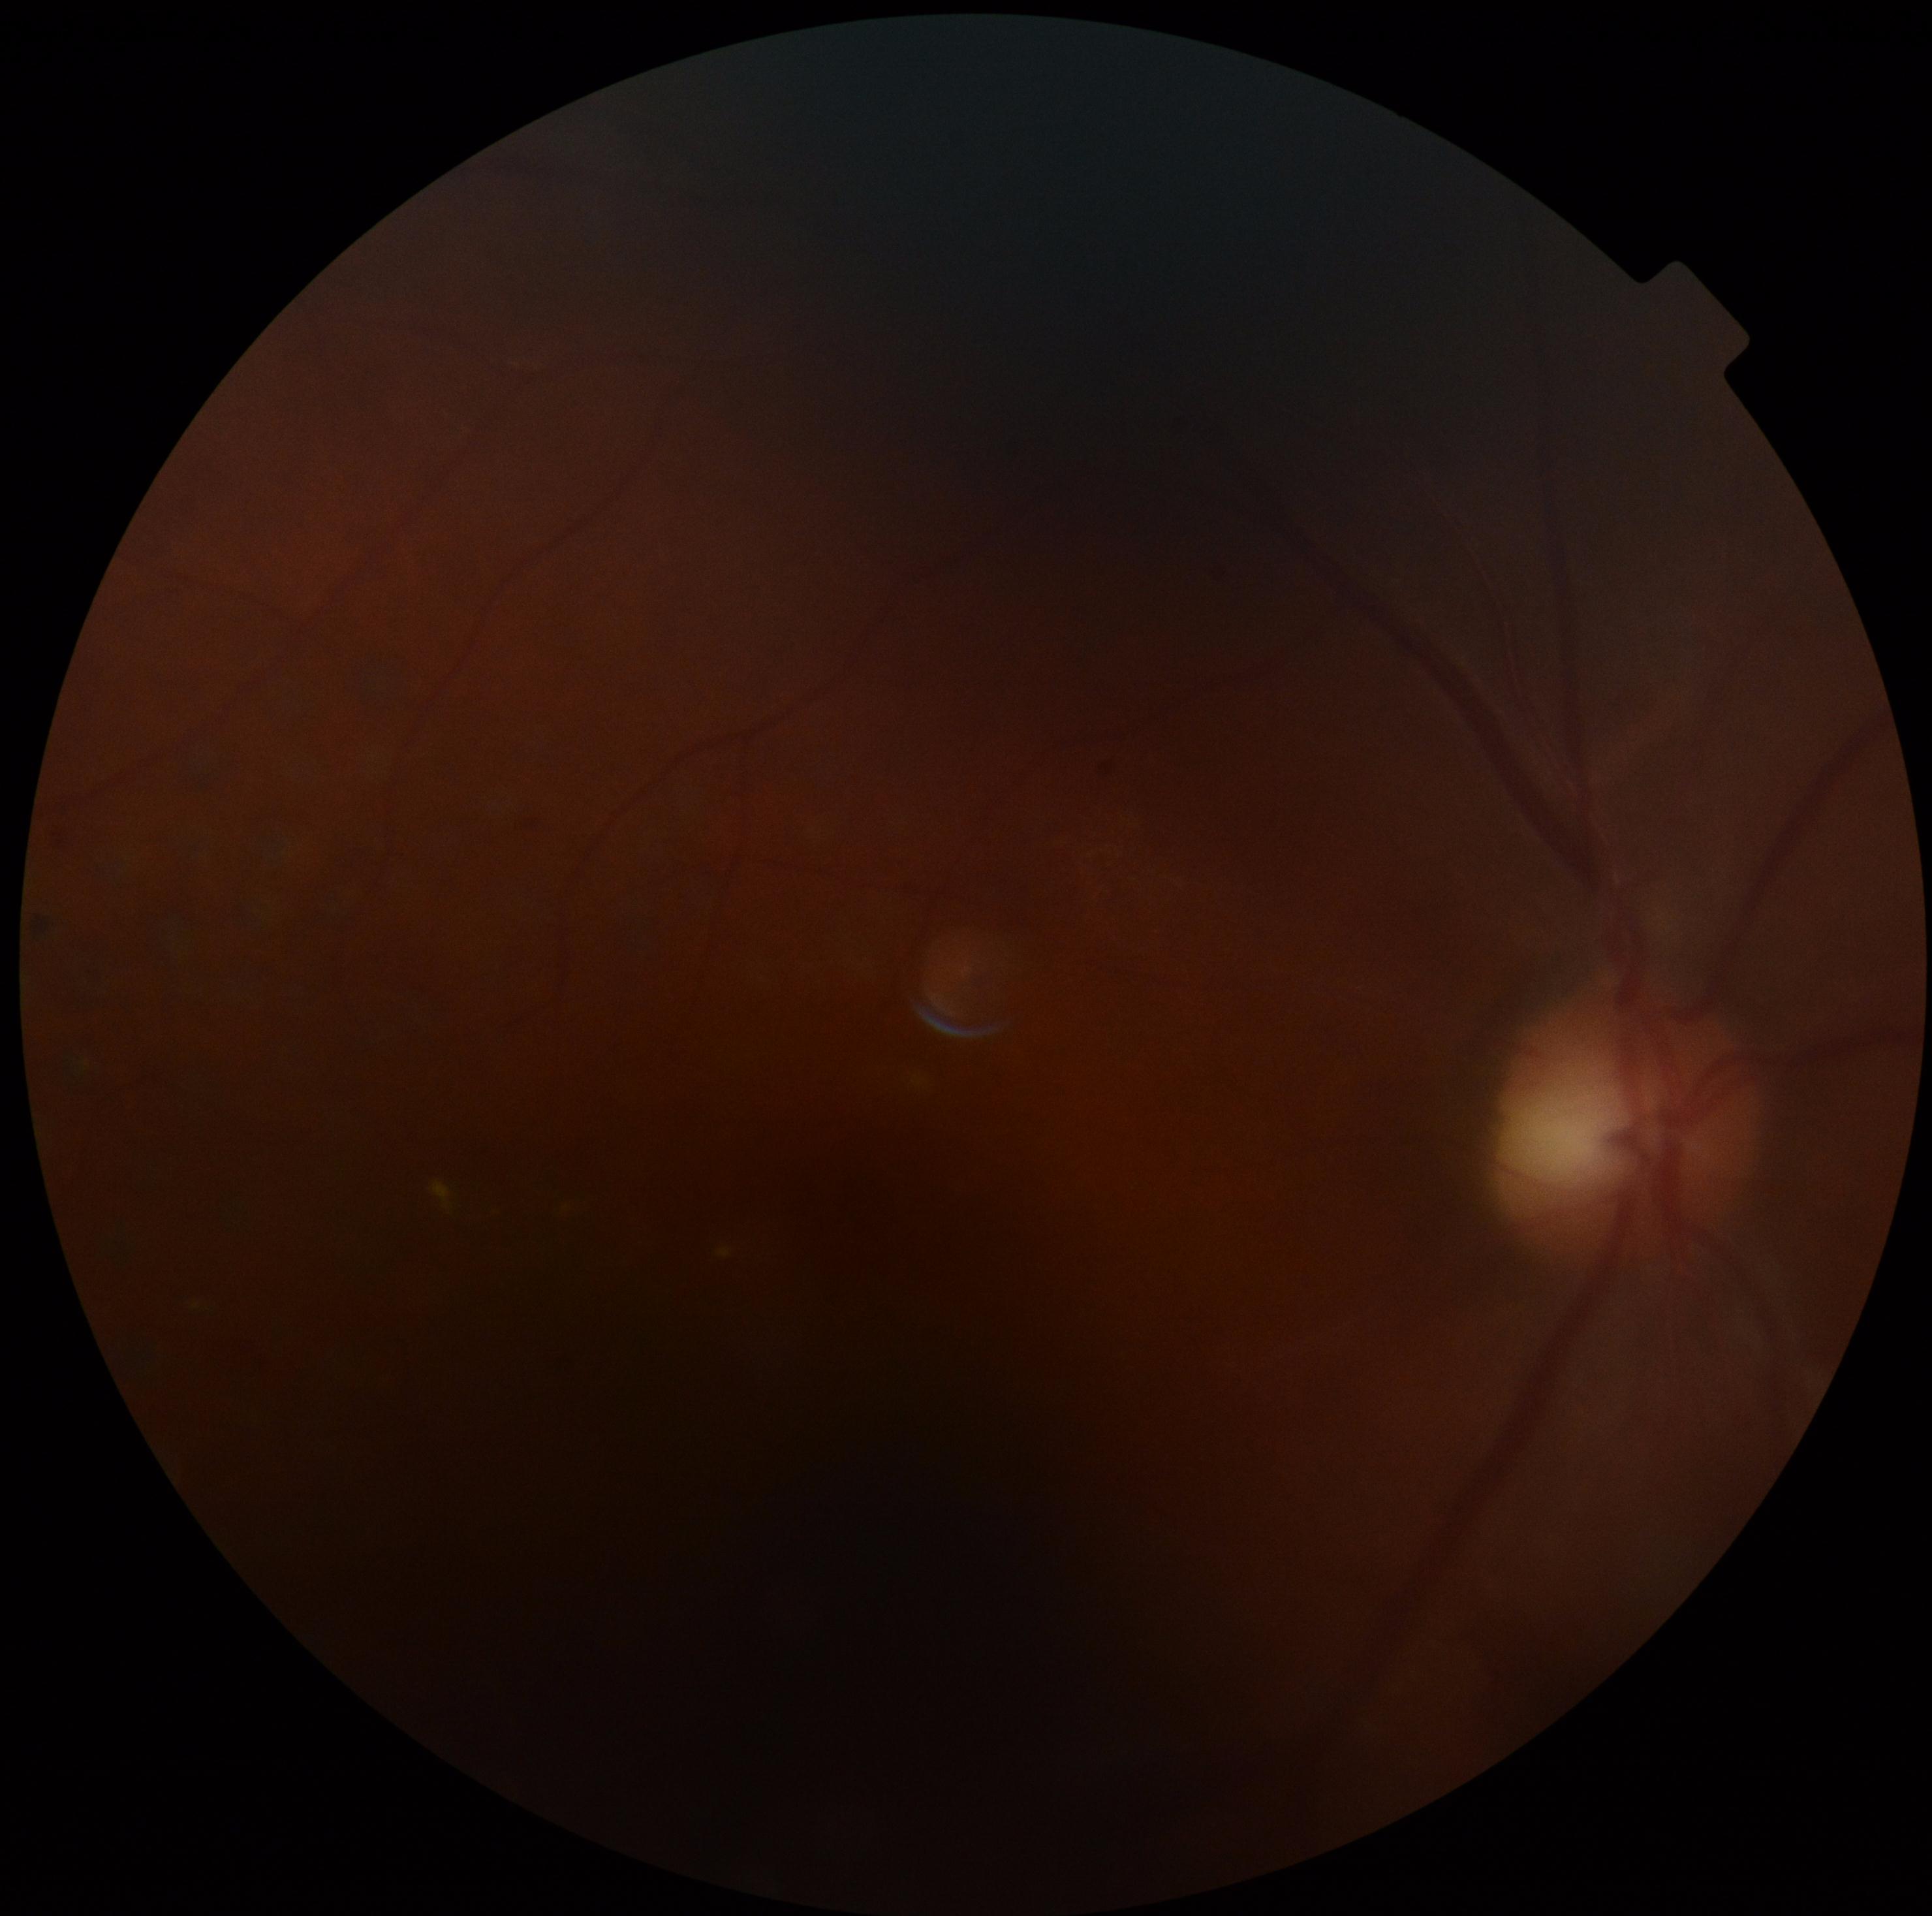
Diabetic retinopathy (DR) is moderate non-proliferative diabetic retinopathy (grade 2).